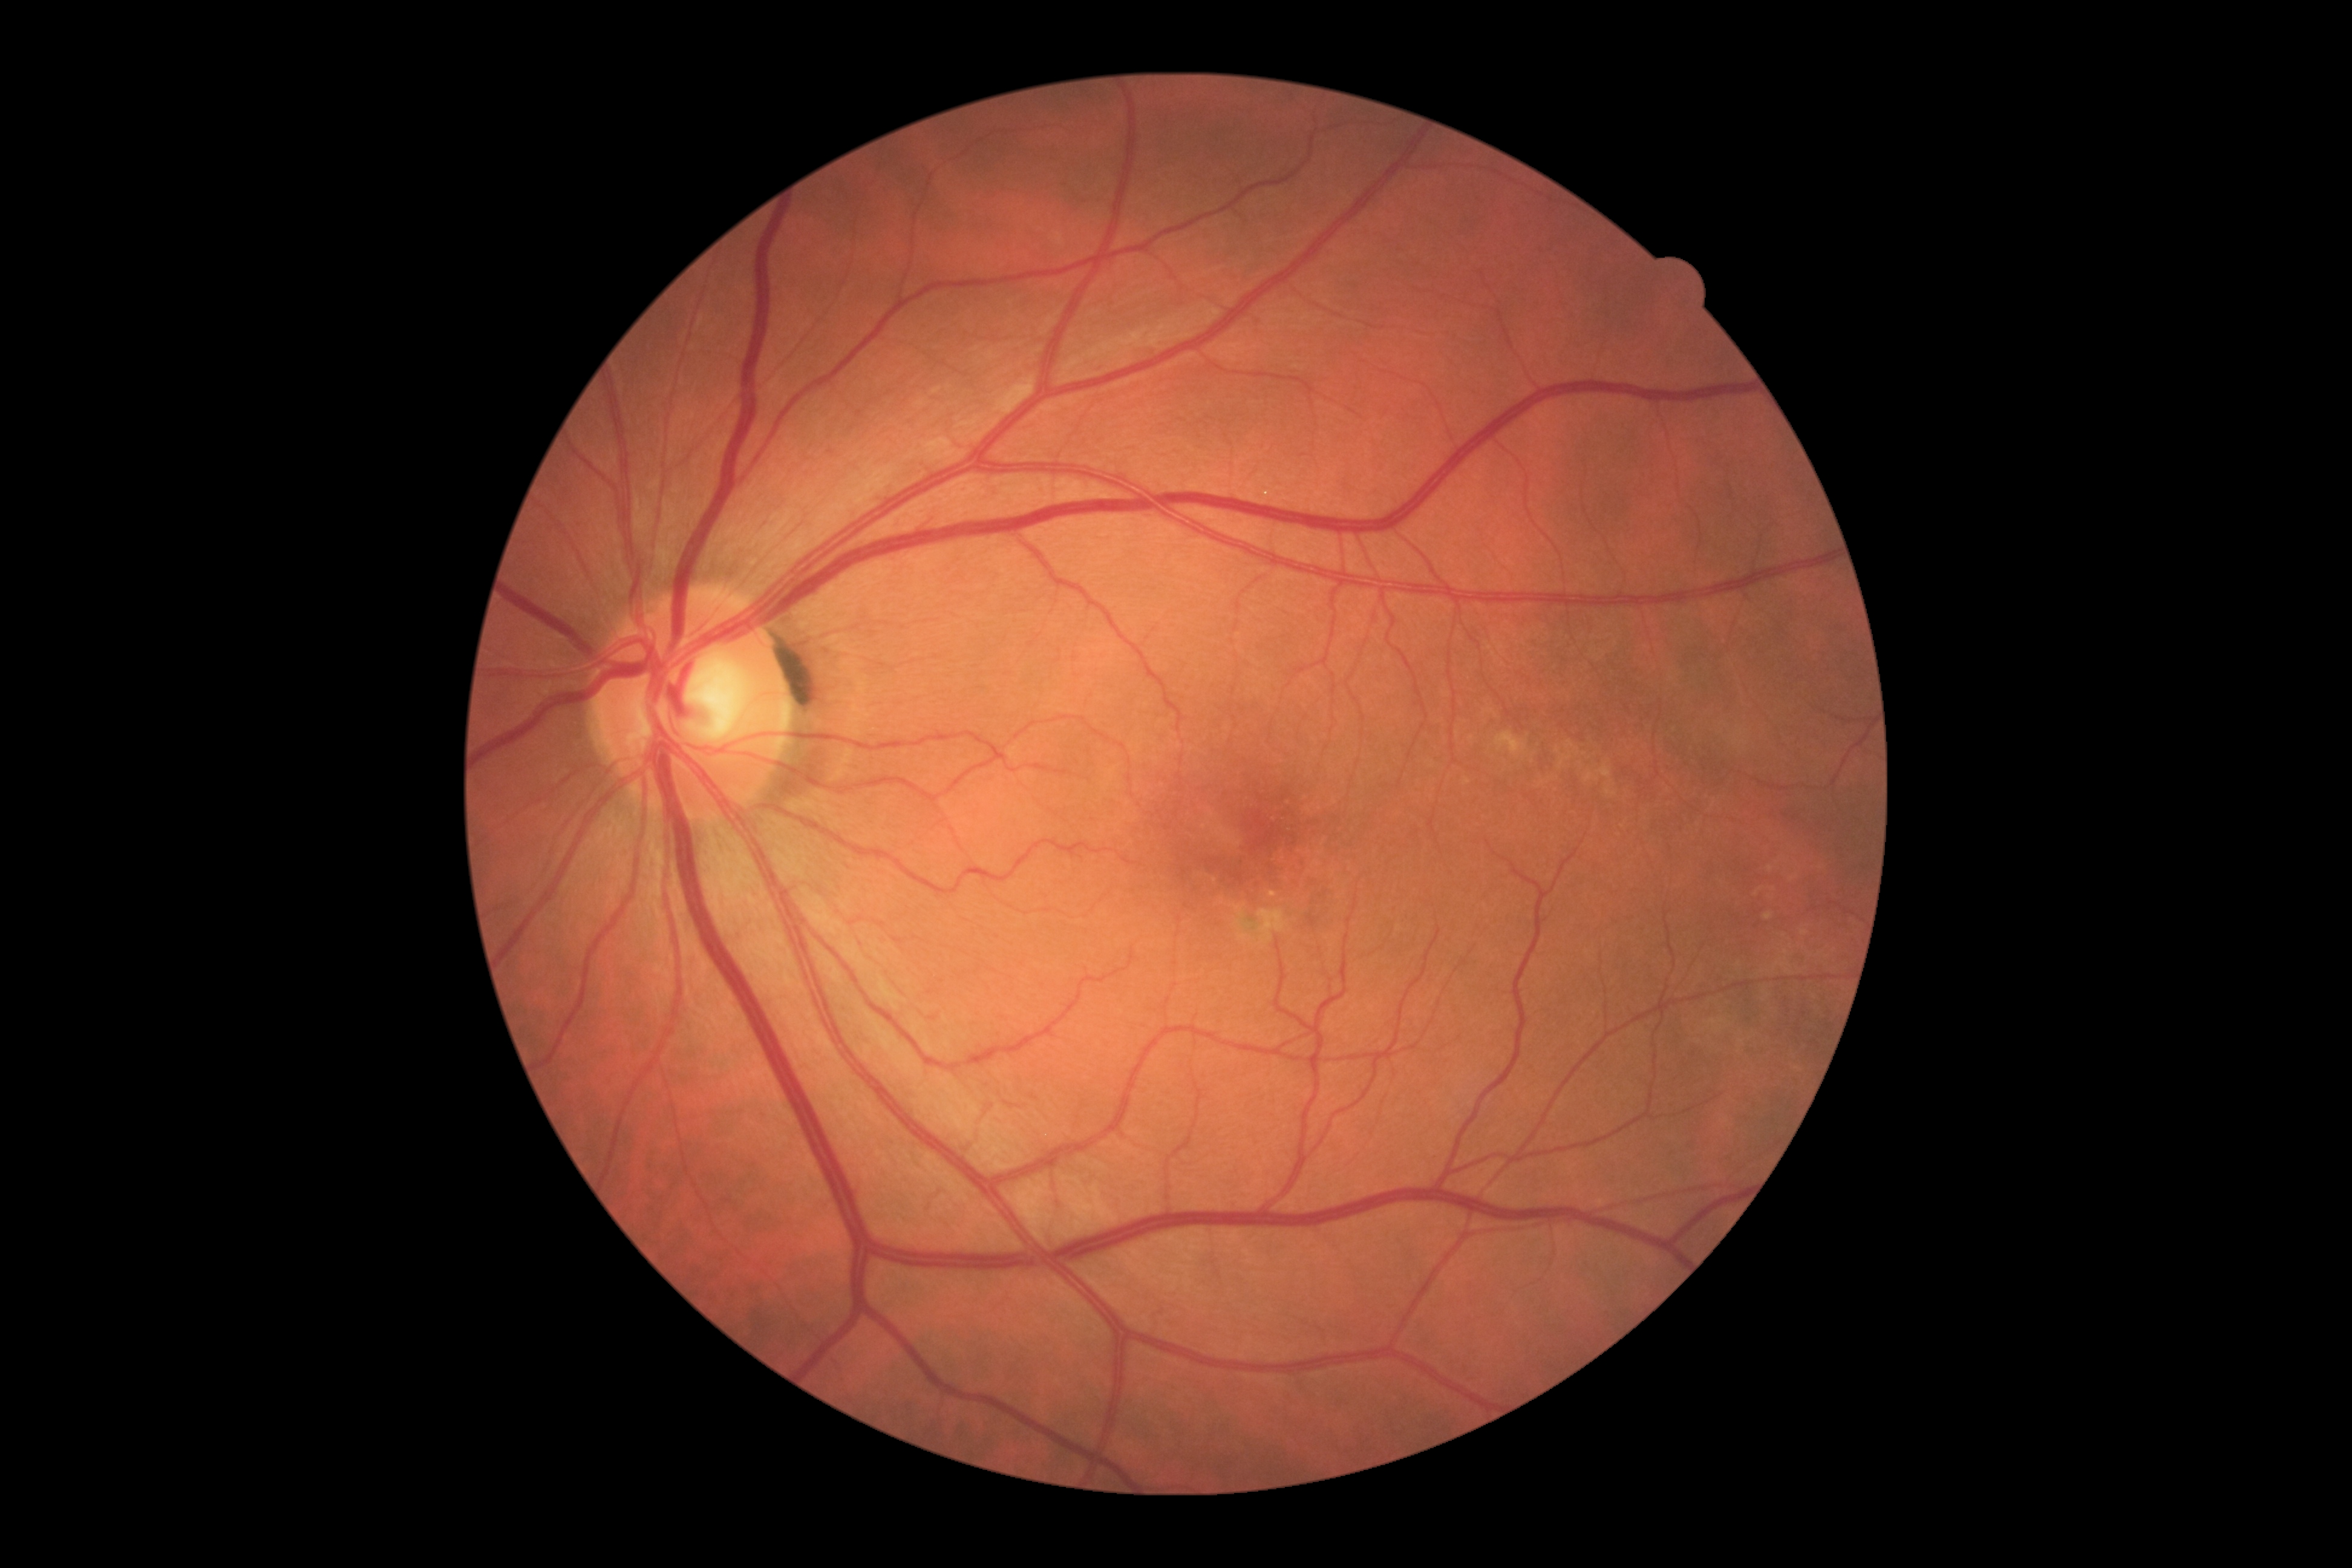
DR is 0 — no visible signs of diabetic retinopathy.